Retinal fundus photograph.
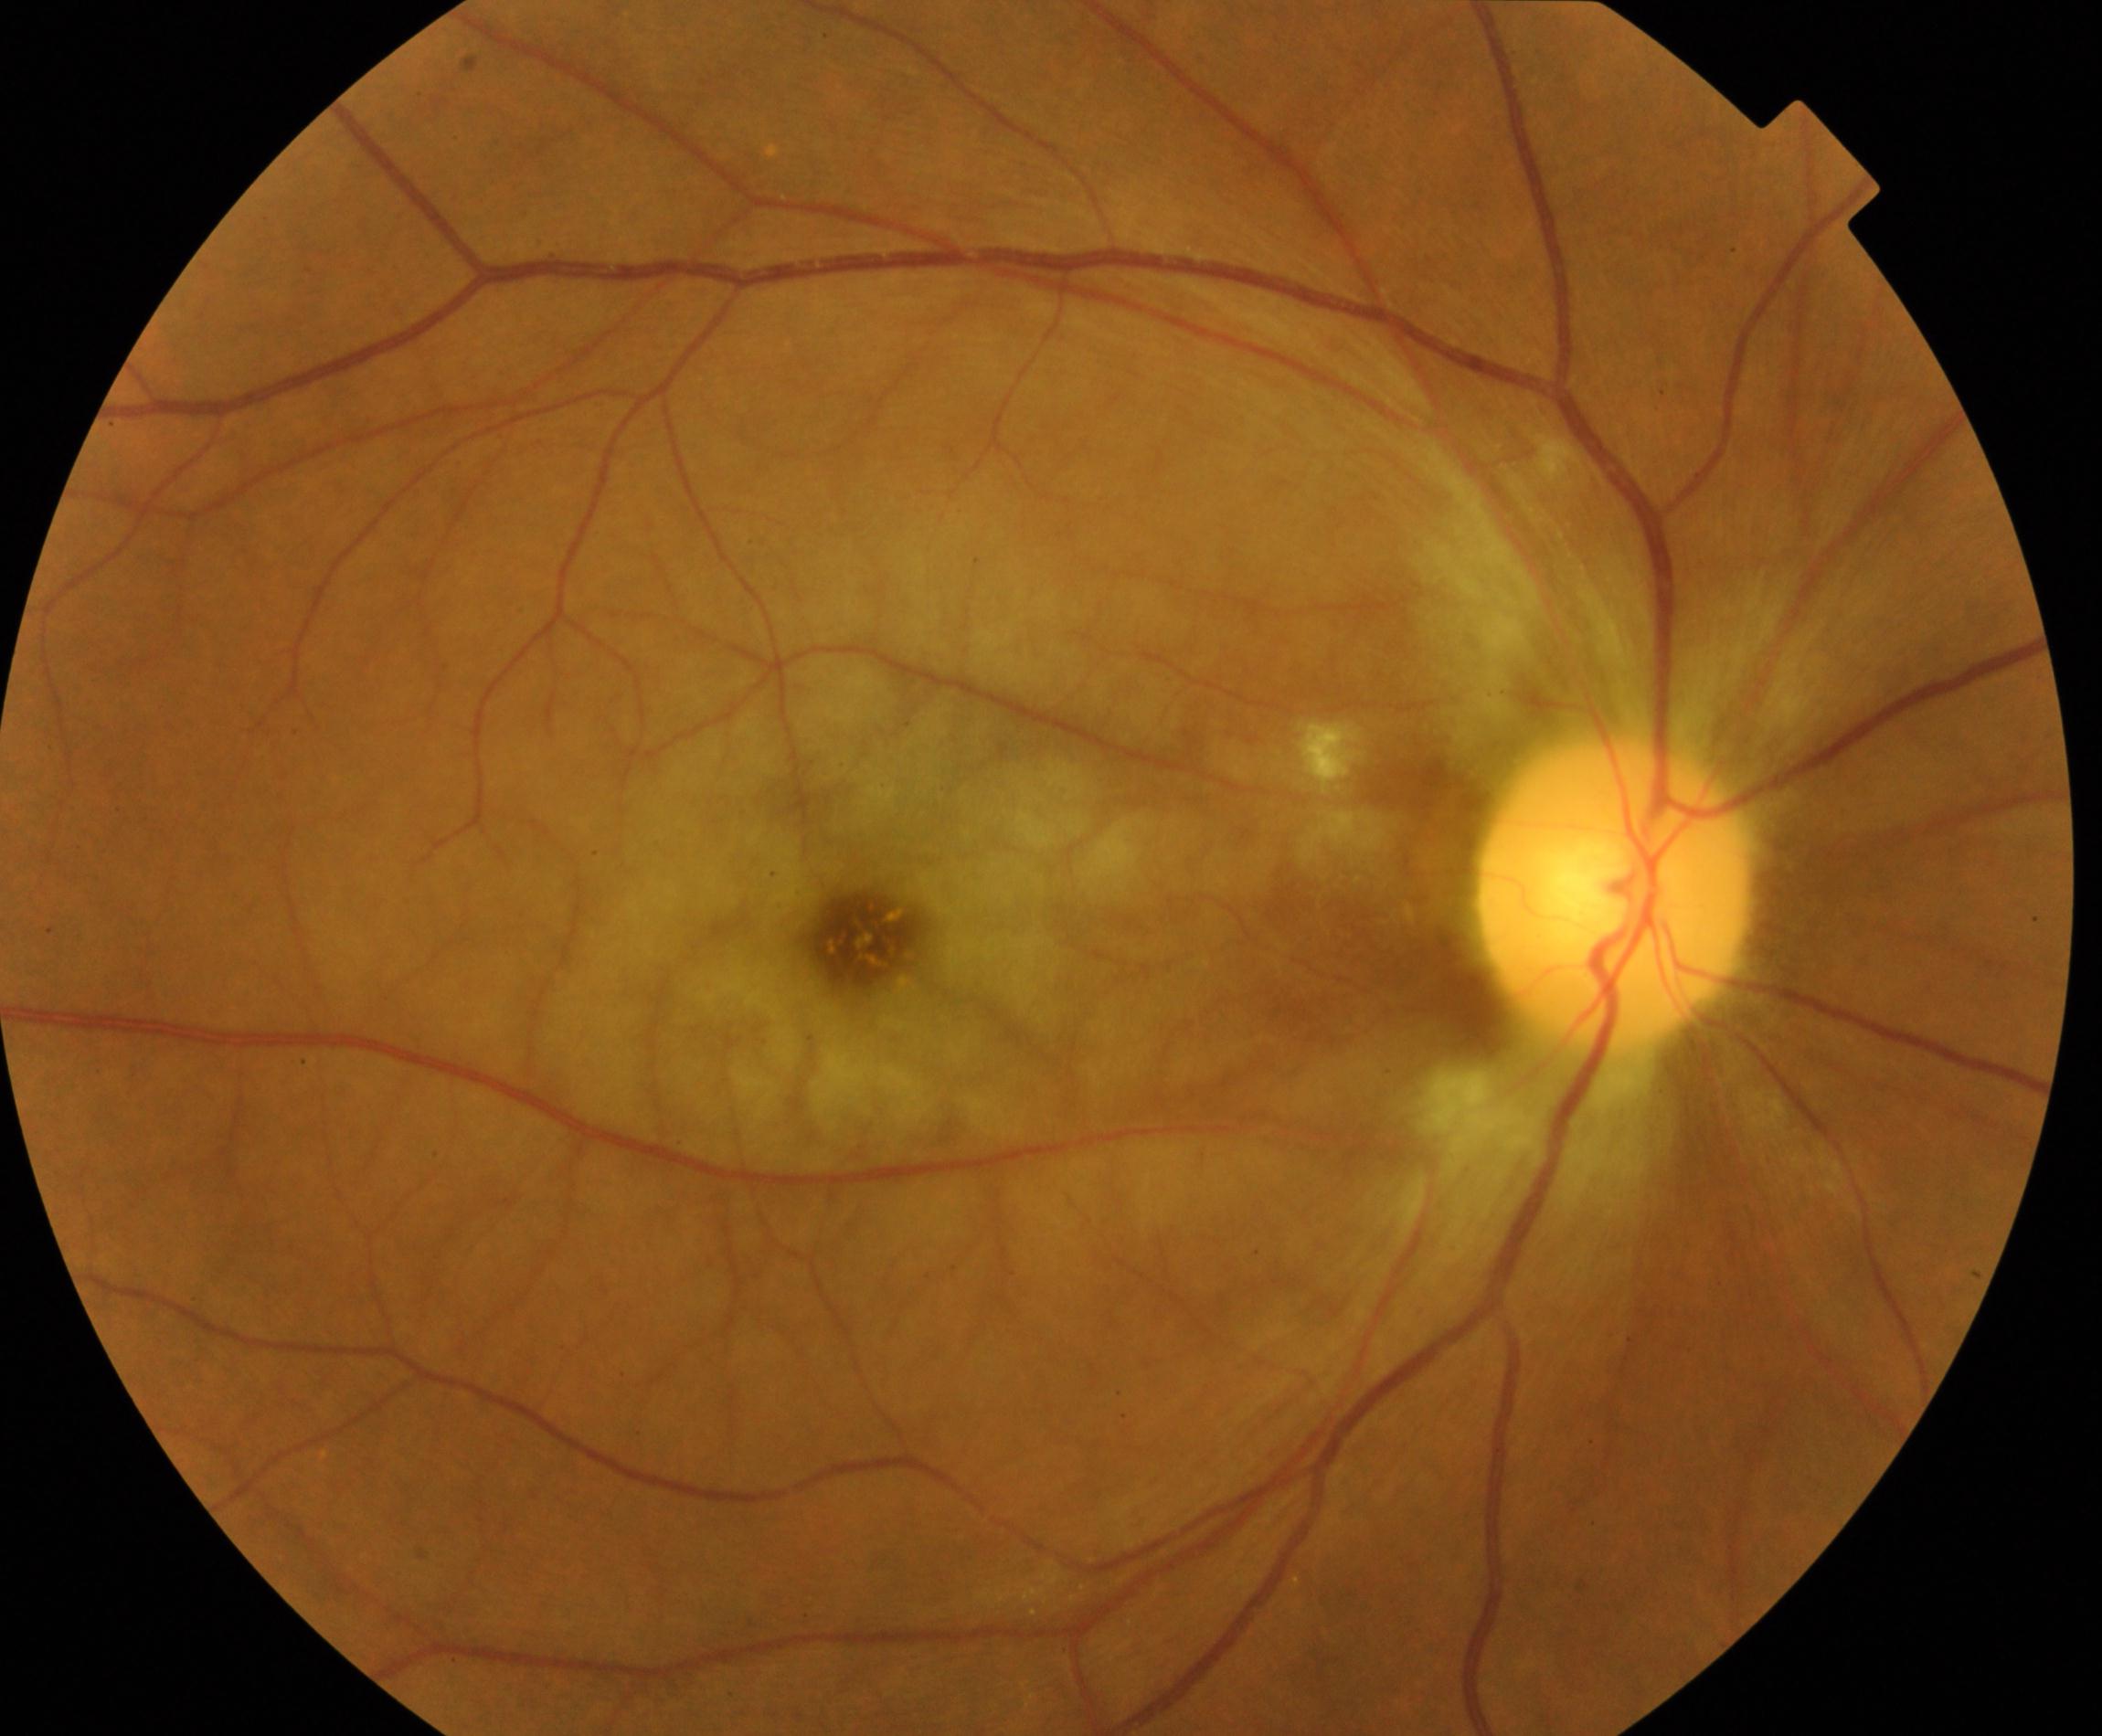

Primary finding: retinal artery occlusion.